FOV: 45 degrees.
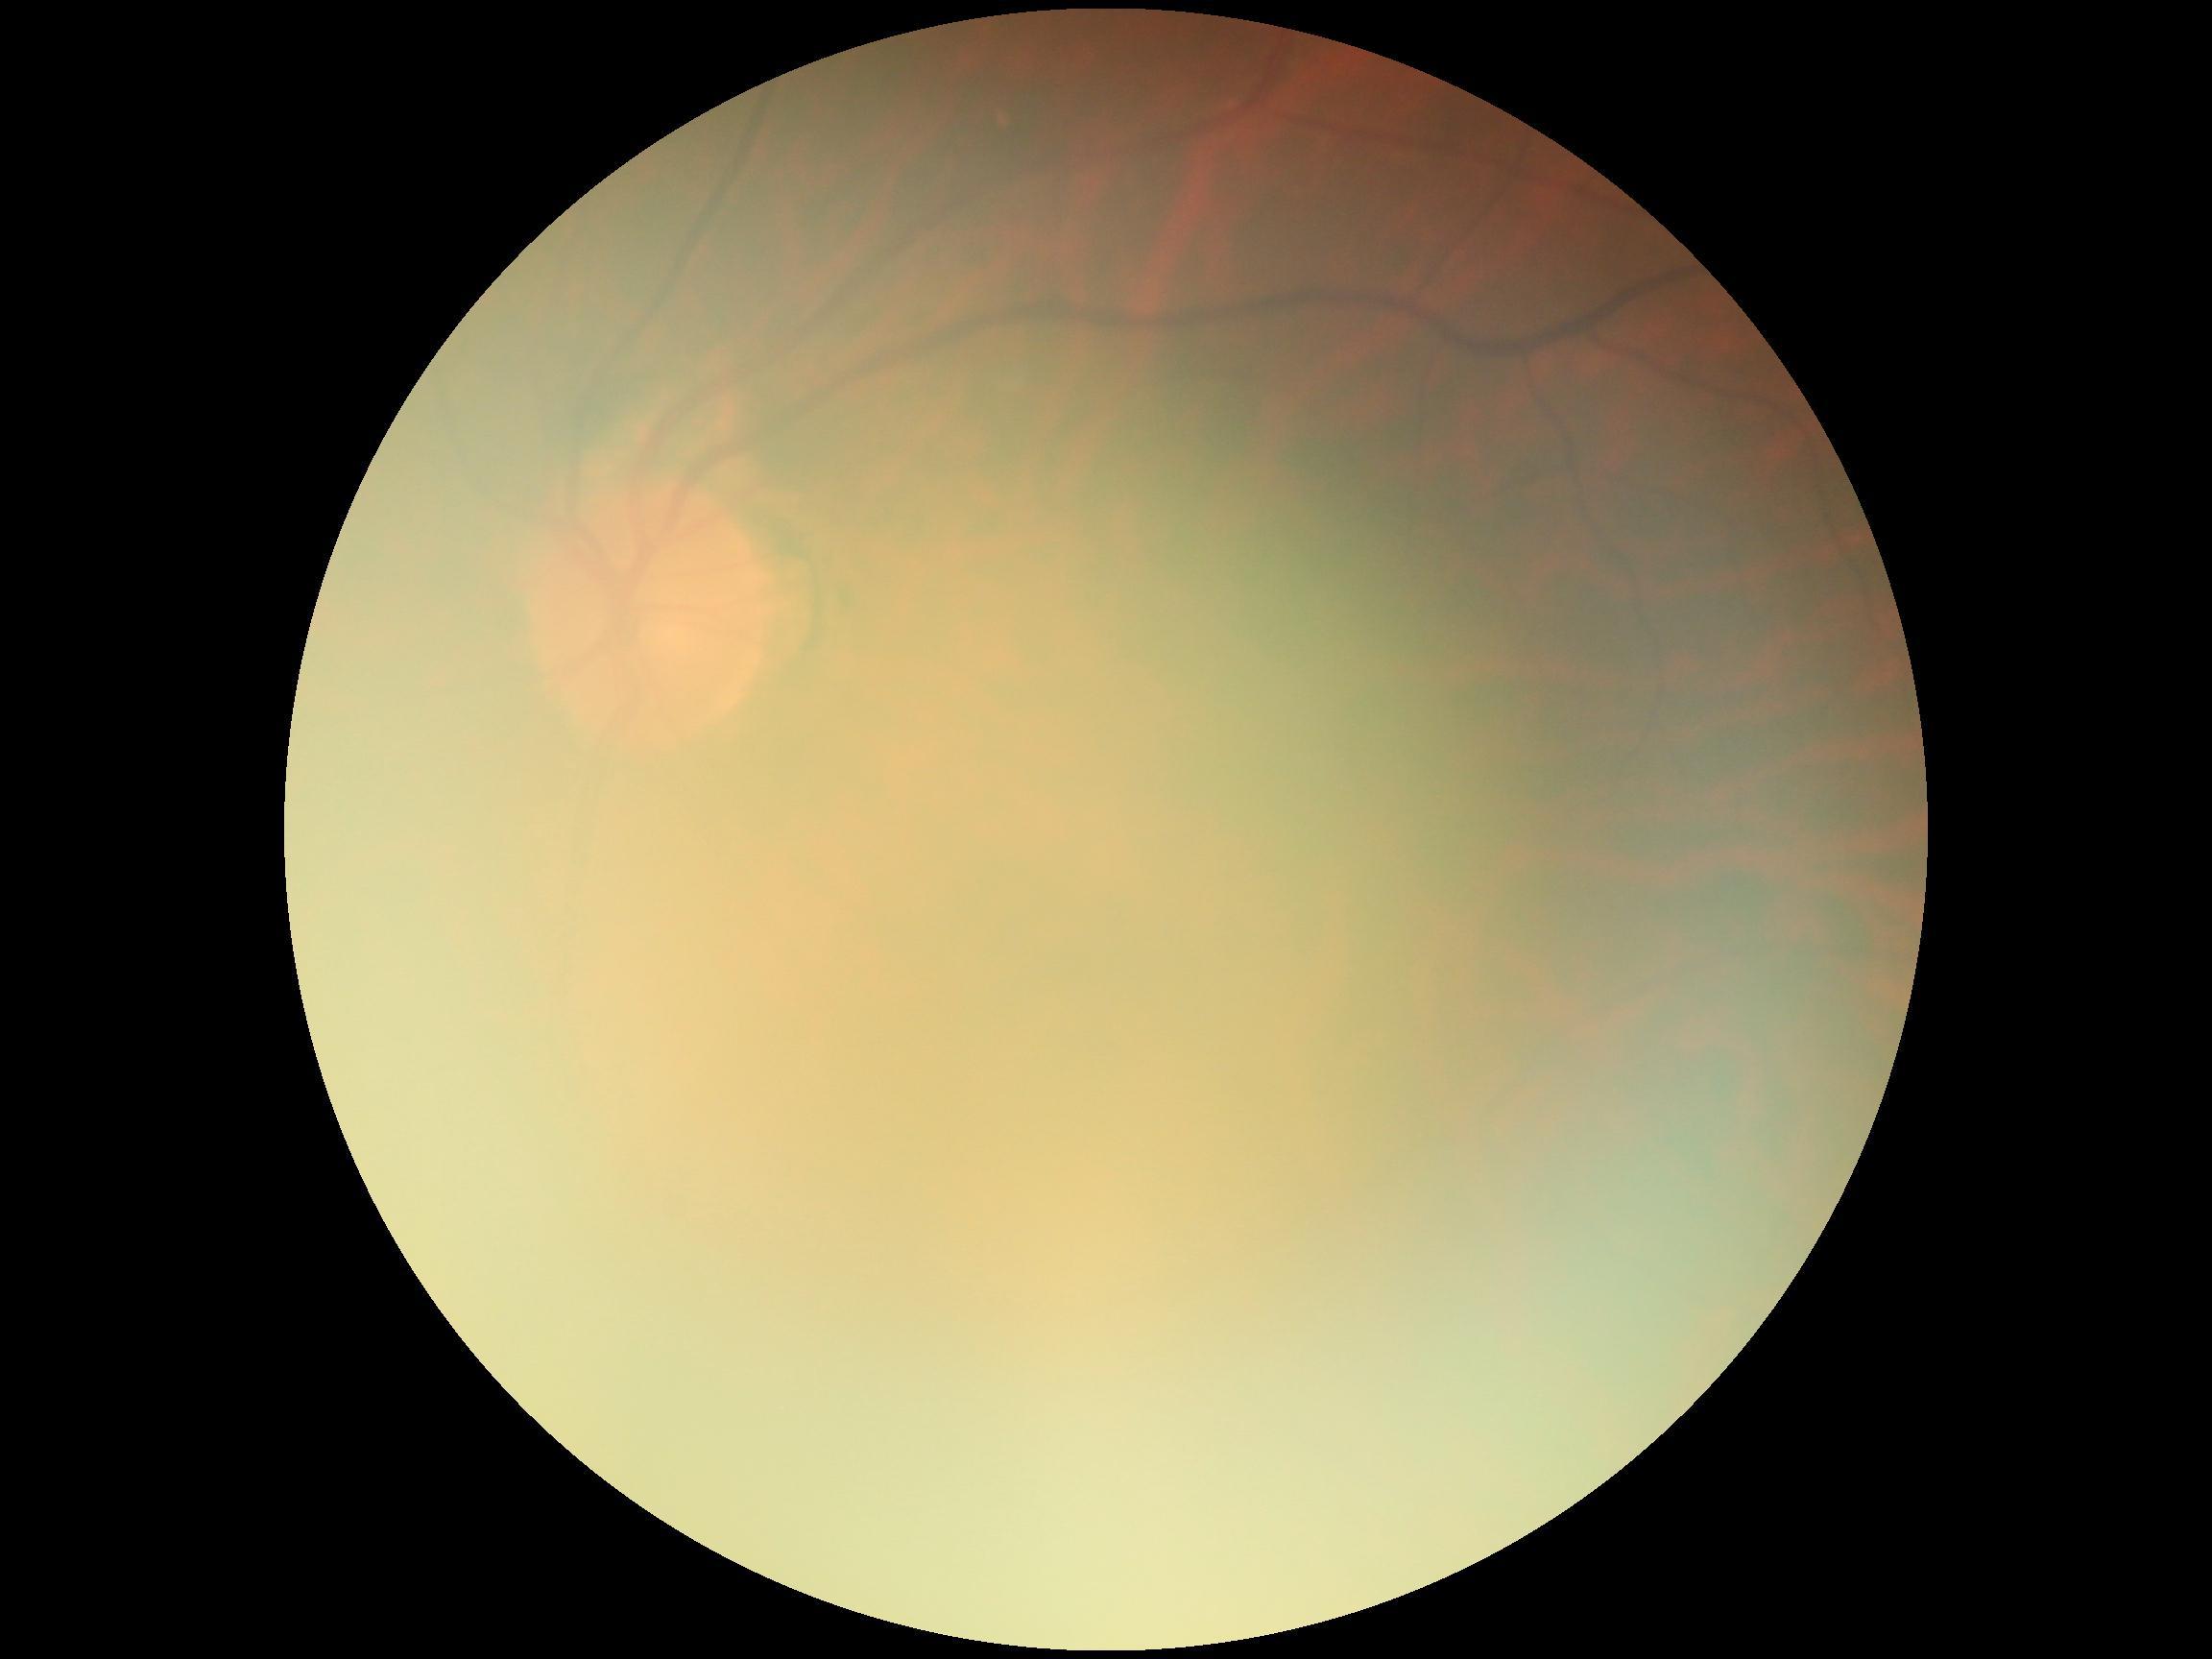 image quality@too poor for DR grading; diabetic retinopathy@ungradable.